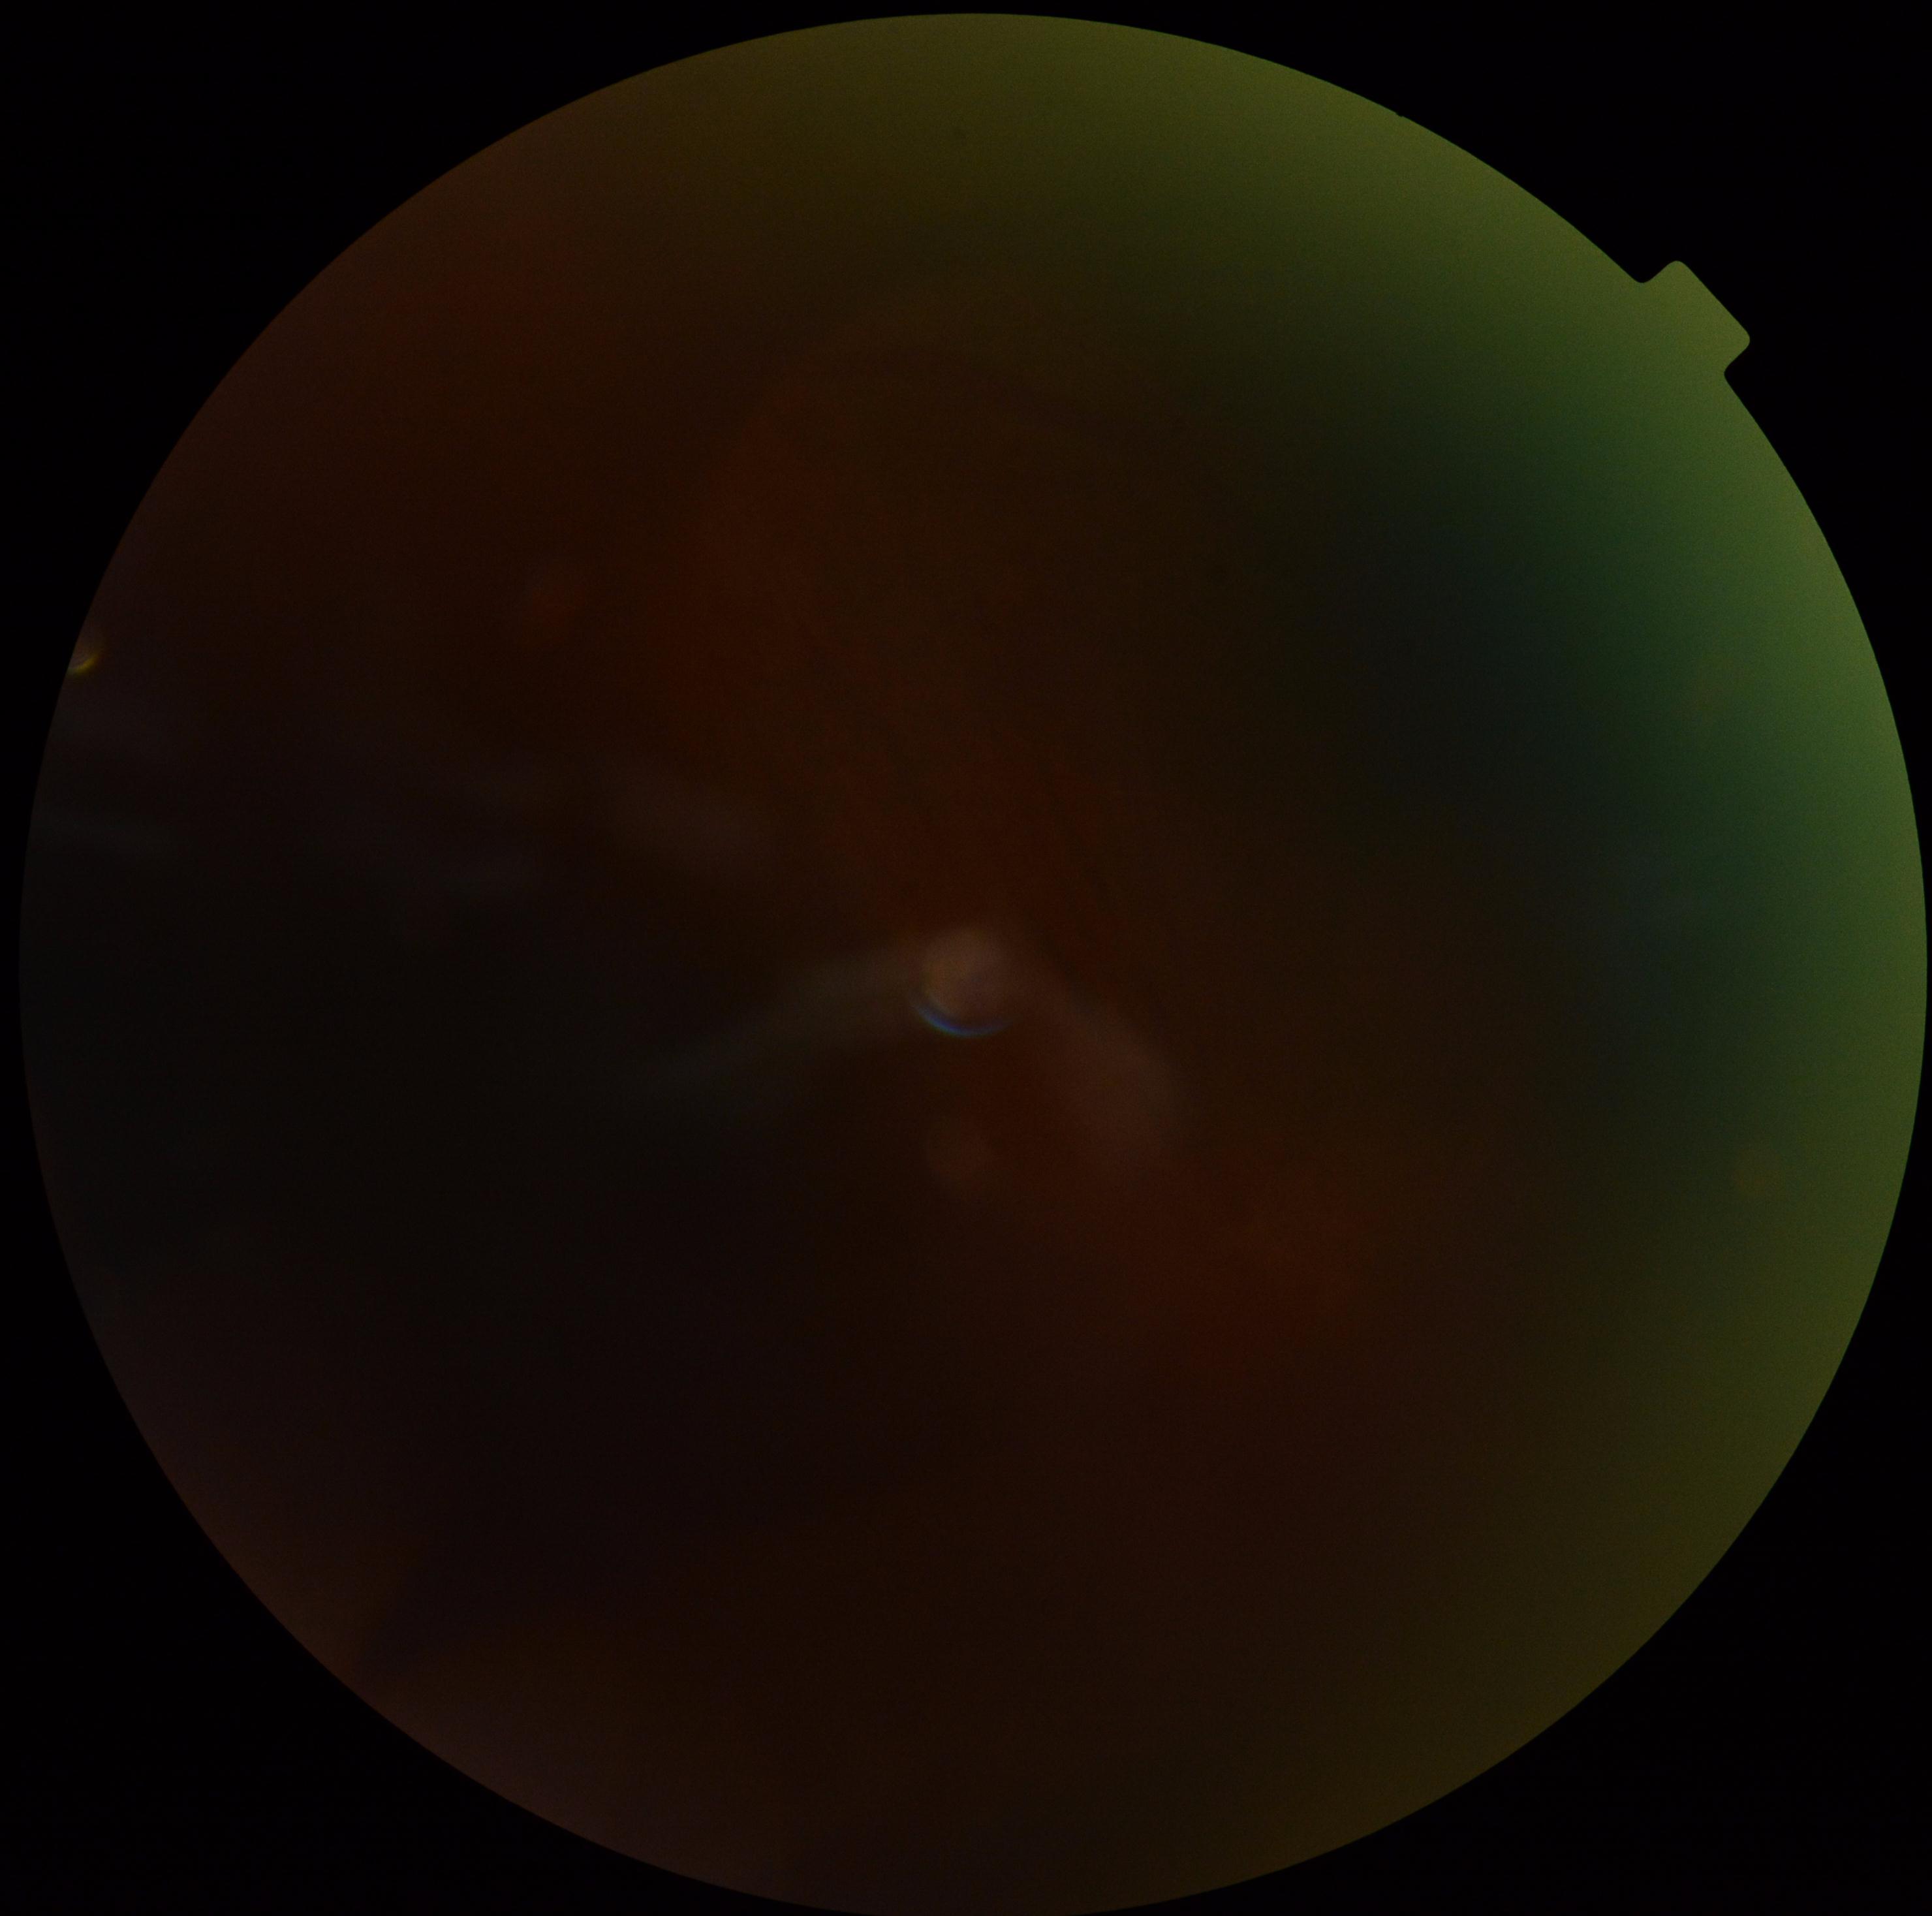

diabetic retinopathy (DR): ungradable